FOV: 45 degrees · diabetic retinopathy graded by the modified Davis classification · nonmydriatic · NIDEK AFC-230 · 848x848: 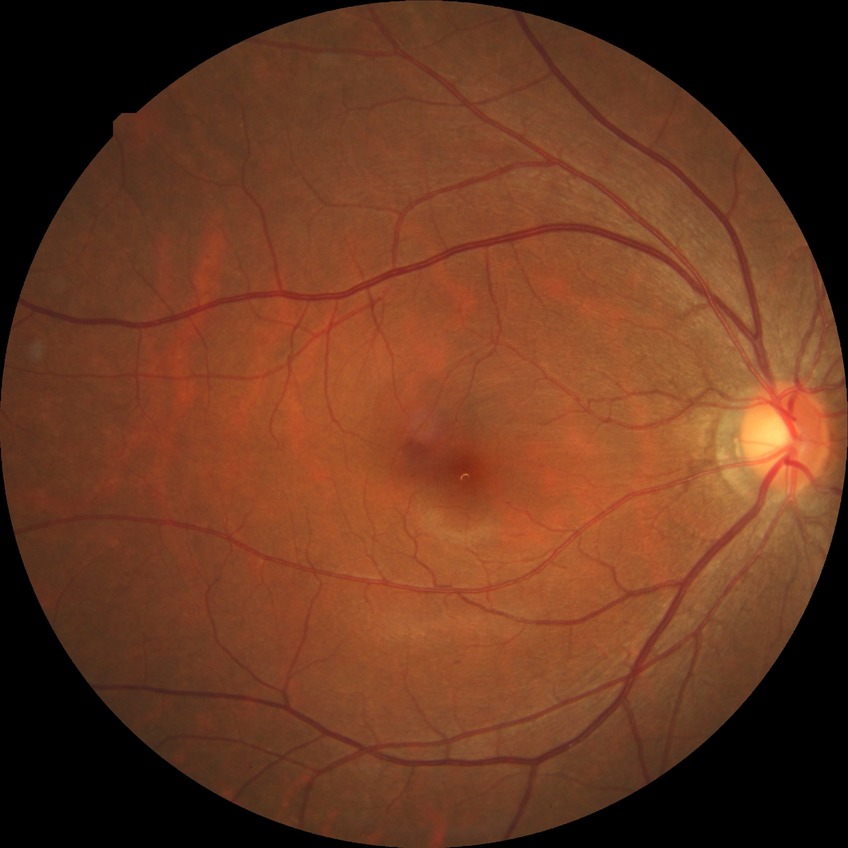
Retinopathy stage is no diabetic retinopathy.